Camera: NIDEK AFC-230 — 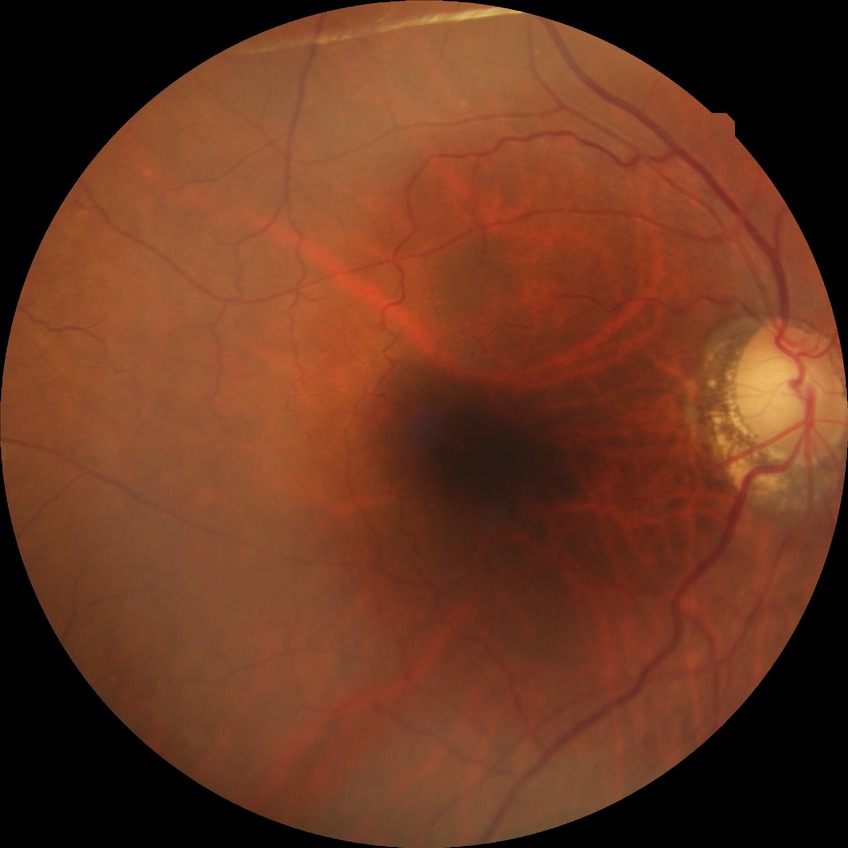
Retinopathy stage is no diabetic retinopathy.